Camera: NIDEK AFC-230, 848 x 848 pixels, color fundus image, modified Davis classification:
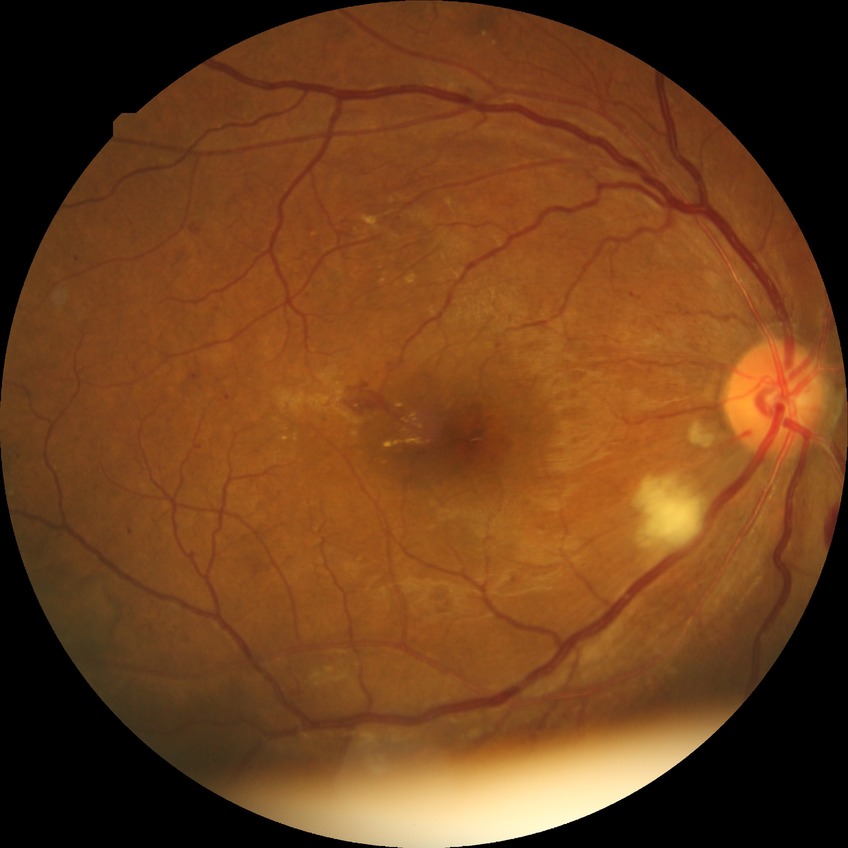 Davis grading = proliferative diabetic retinopathy